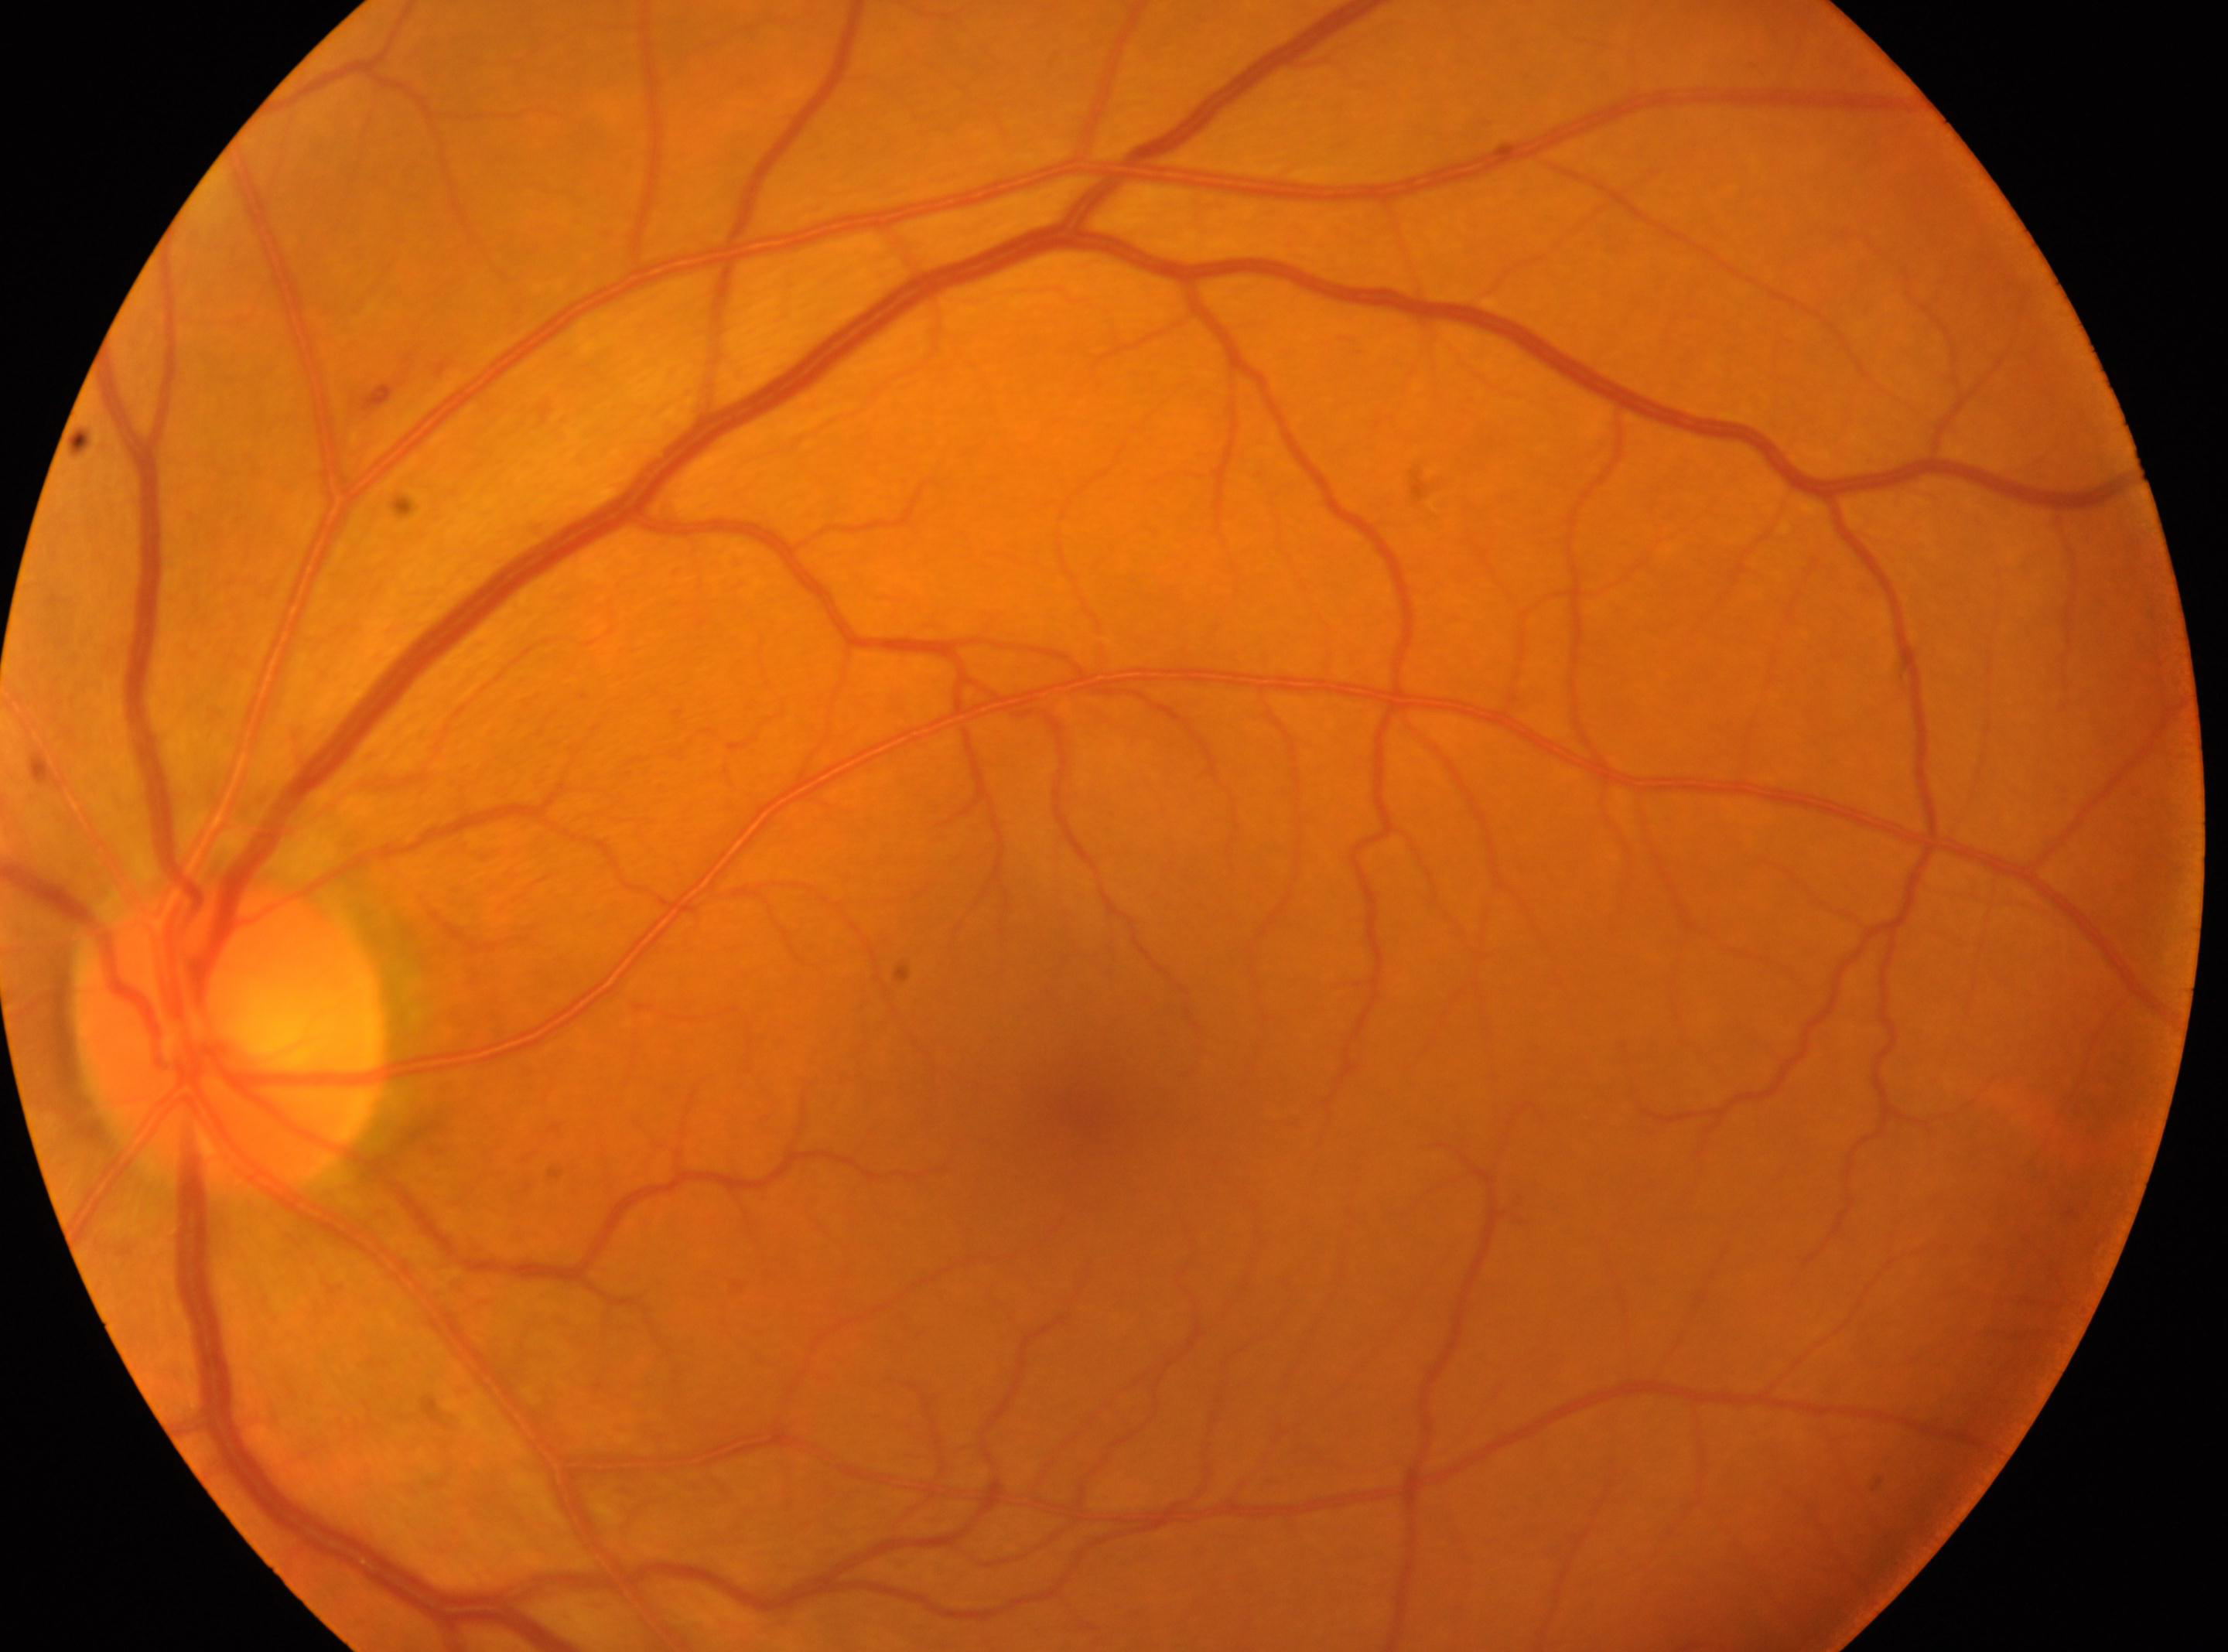
  optic_disc: (x=229, y=1033)
  fovea: (x=1082, y=1109)
  dr_grade: 1
  eye: the left eye
  dr_category: non-proliferative diabetic retinopathy